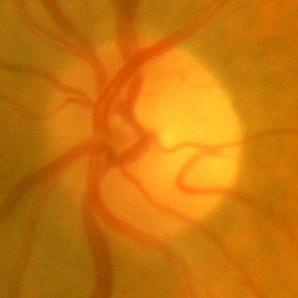 No glaucomatous optic neuropathy.